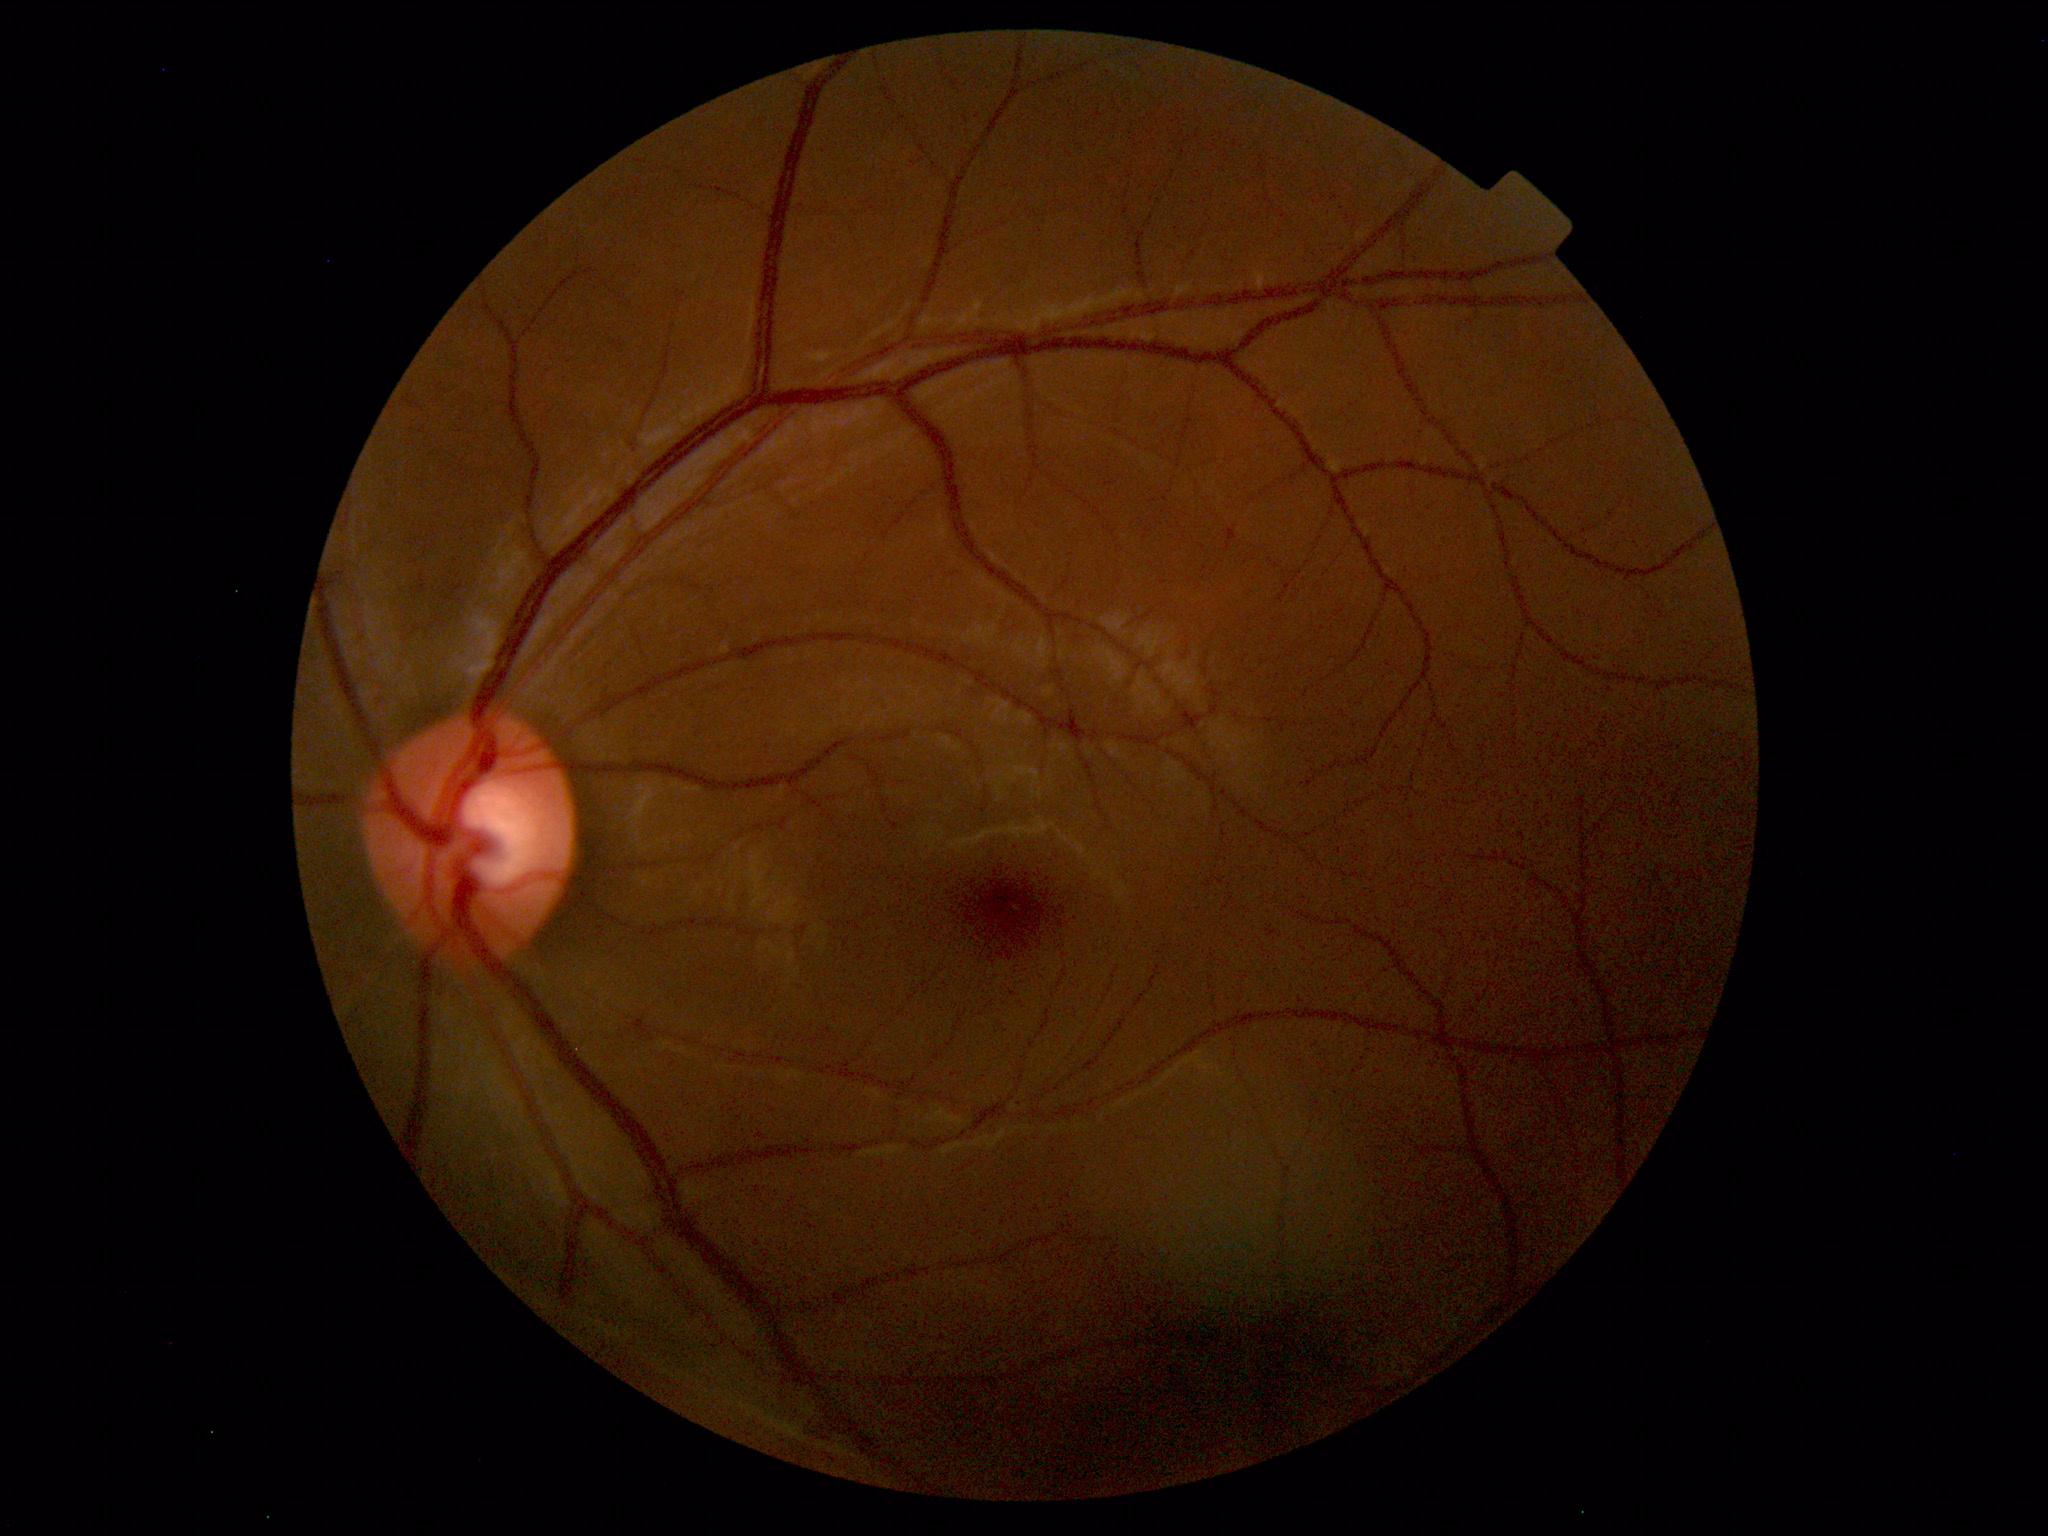 Unremarkable color fundus photograph.